Color fundus image.
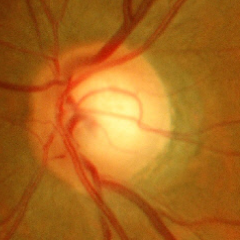

Demonstrates no glaucomatous findings.